Pediatric wide-field fundus photograph; Phoenix ICON, 100° FOV: 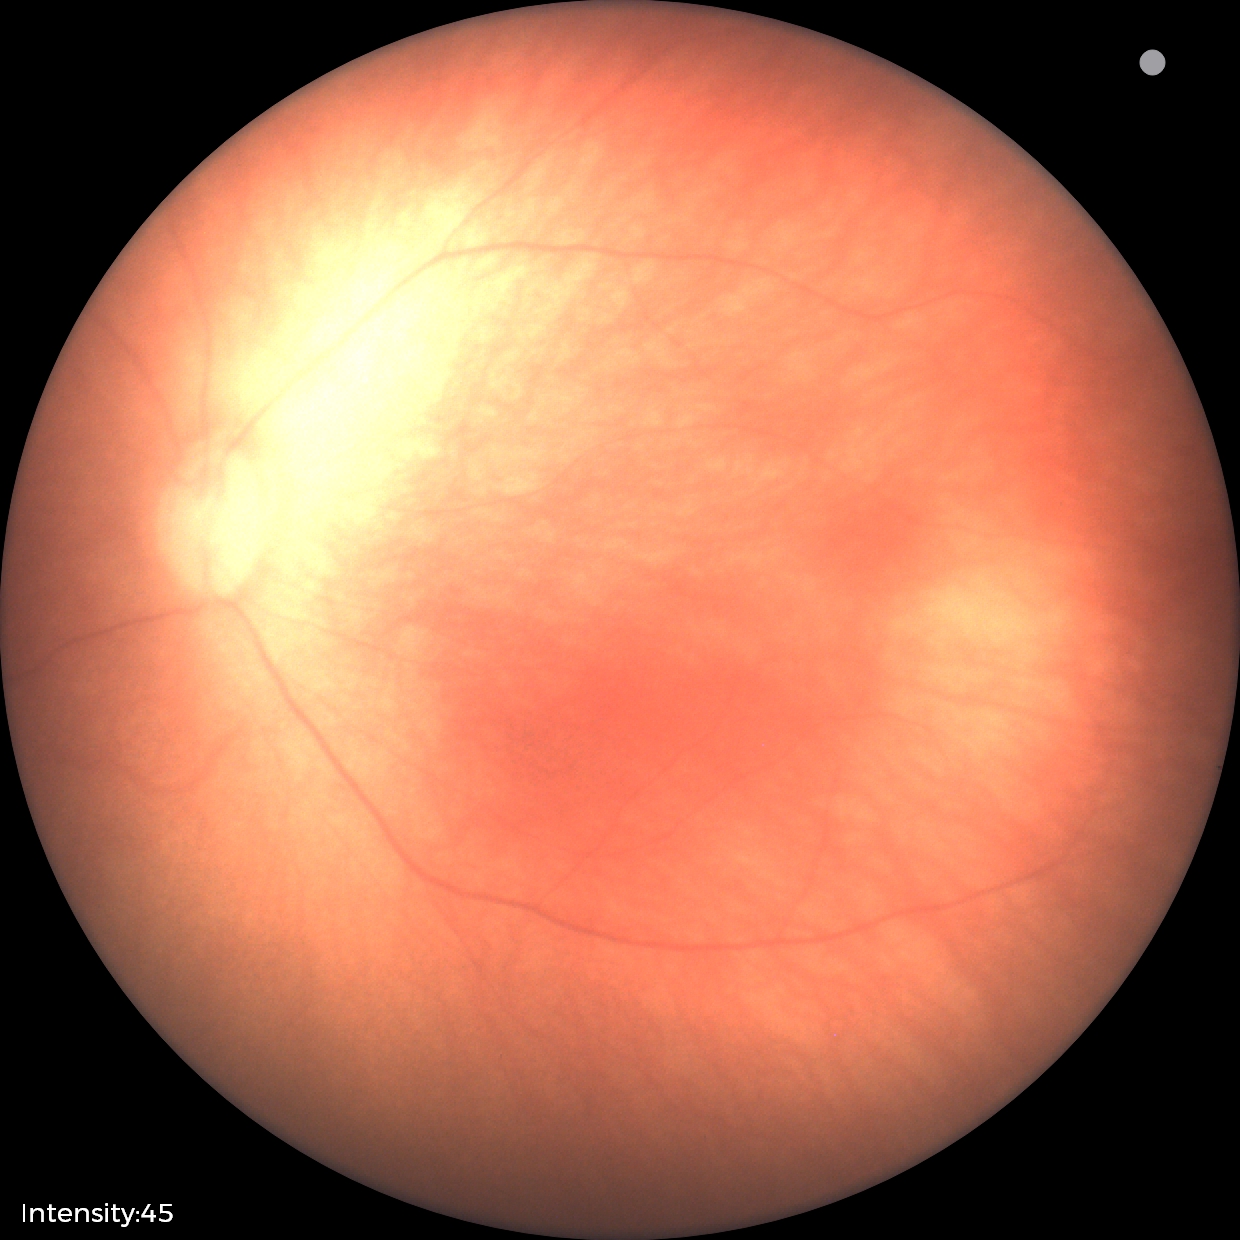 Impression: physiological appearance.